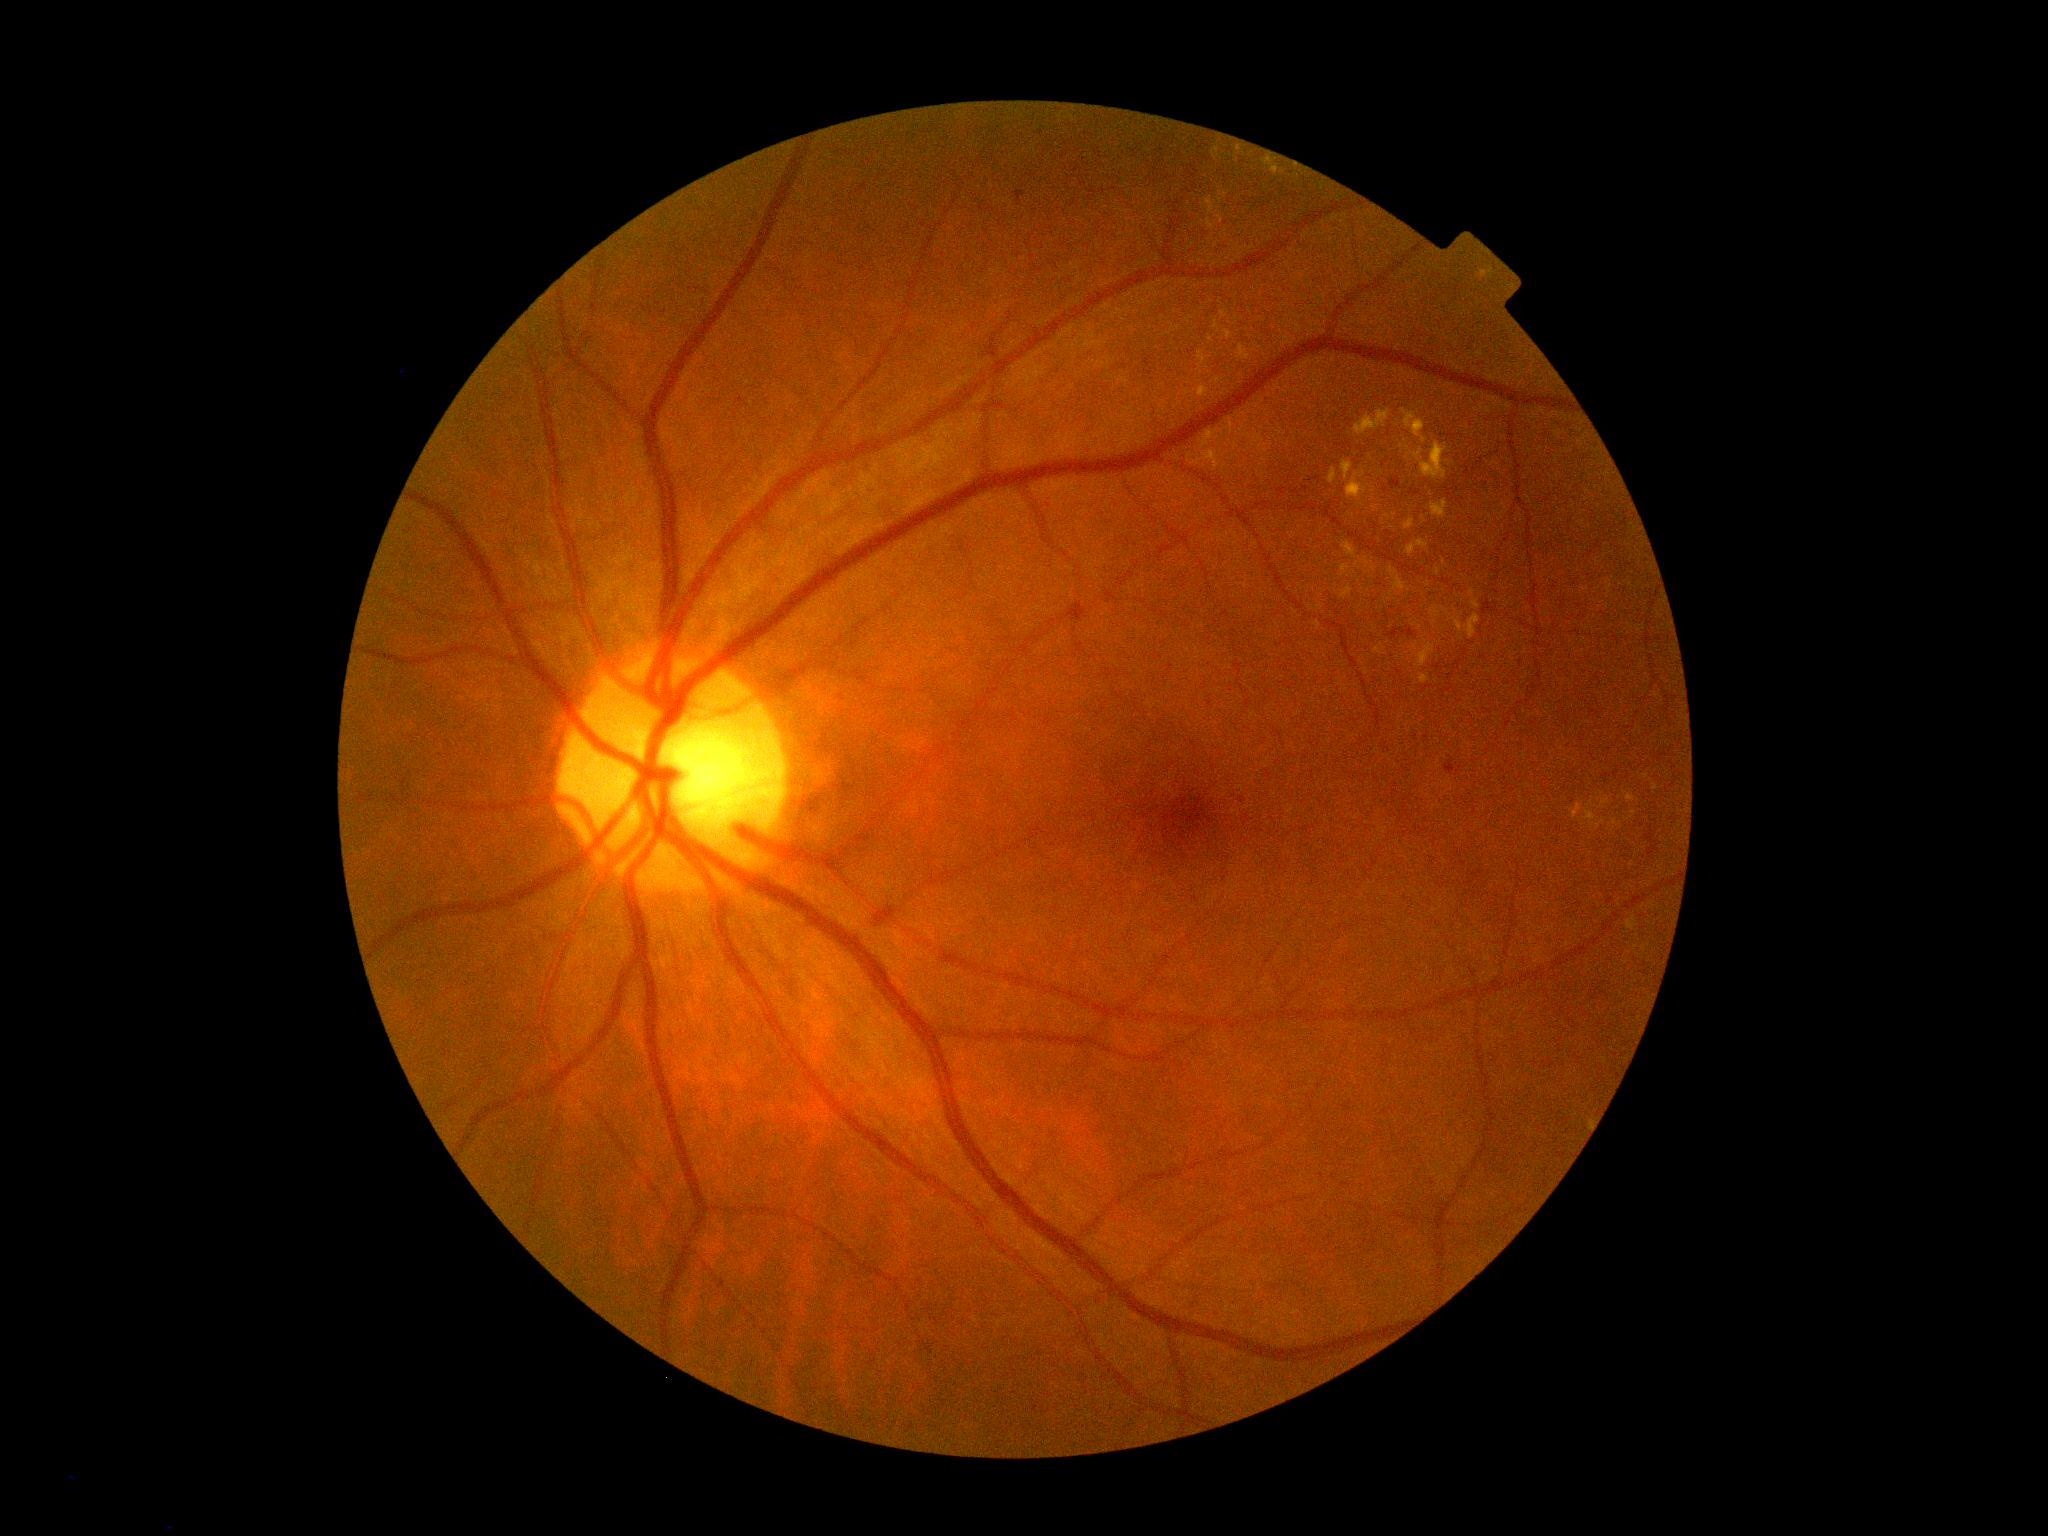
DR stage: moderate non-proliferative diabetic retinopathy (grade 2) — more than just microaneurysms but less than severe NPDR